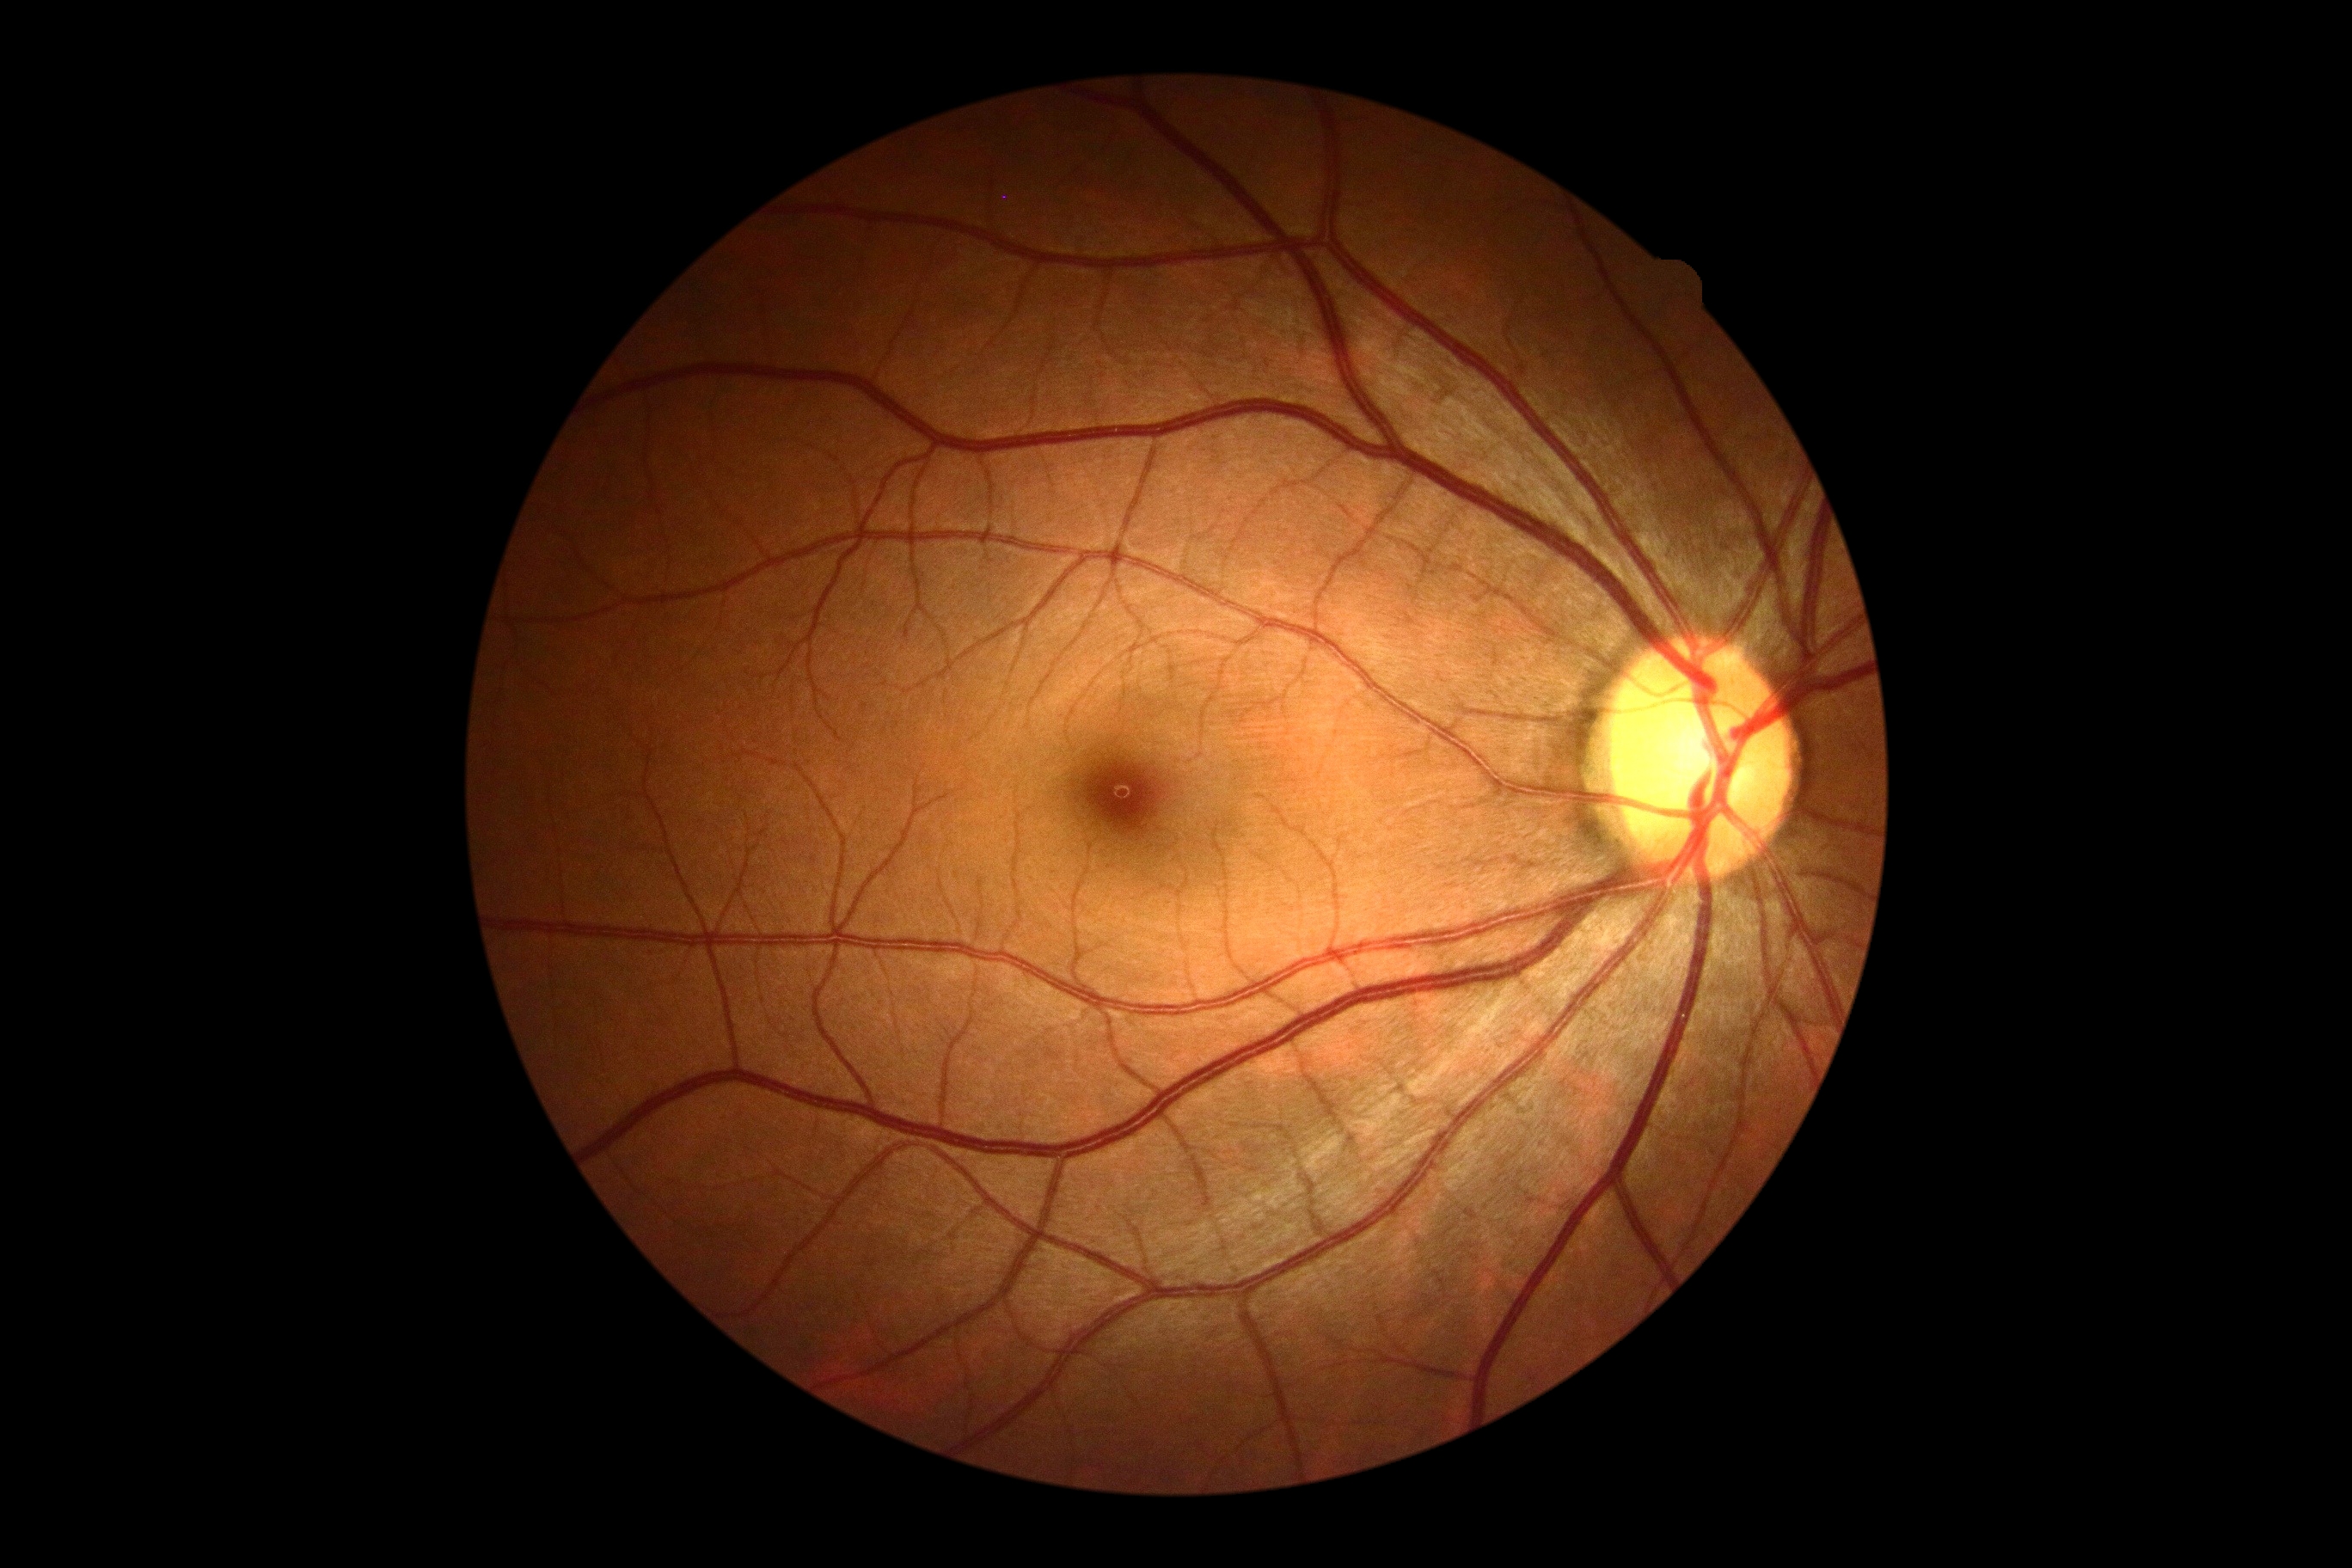 DR: grade 0.